Retinal fundus photograph · image size 2212x1659 · 45° FOV:
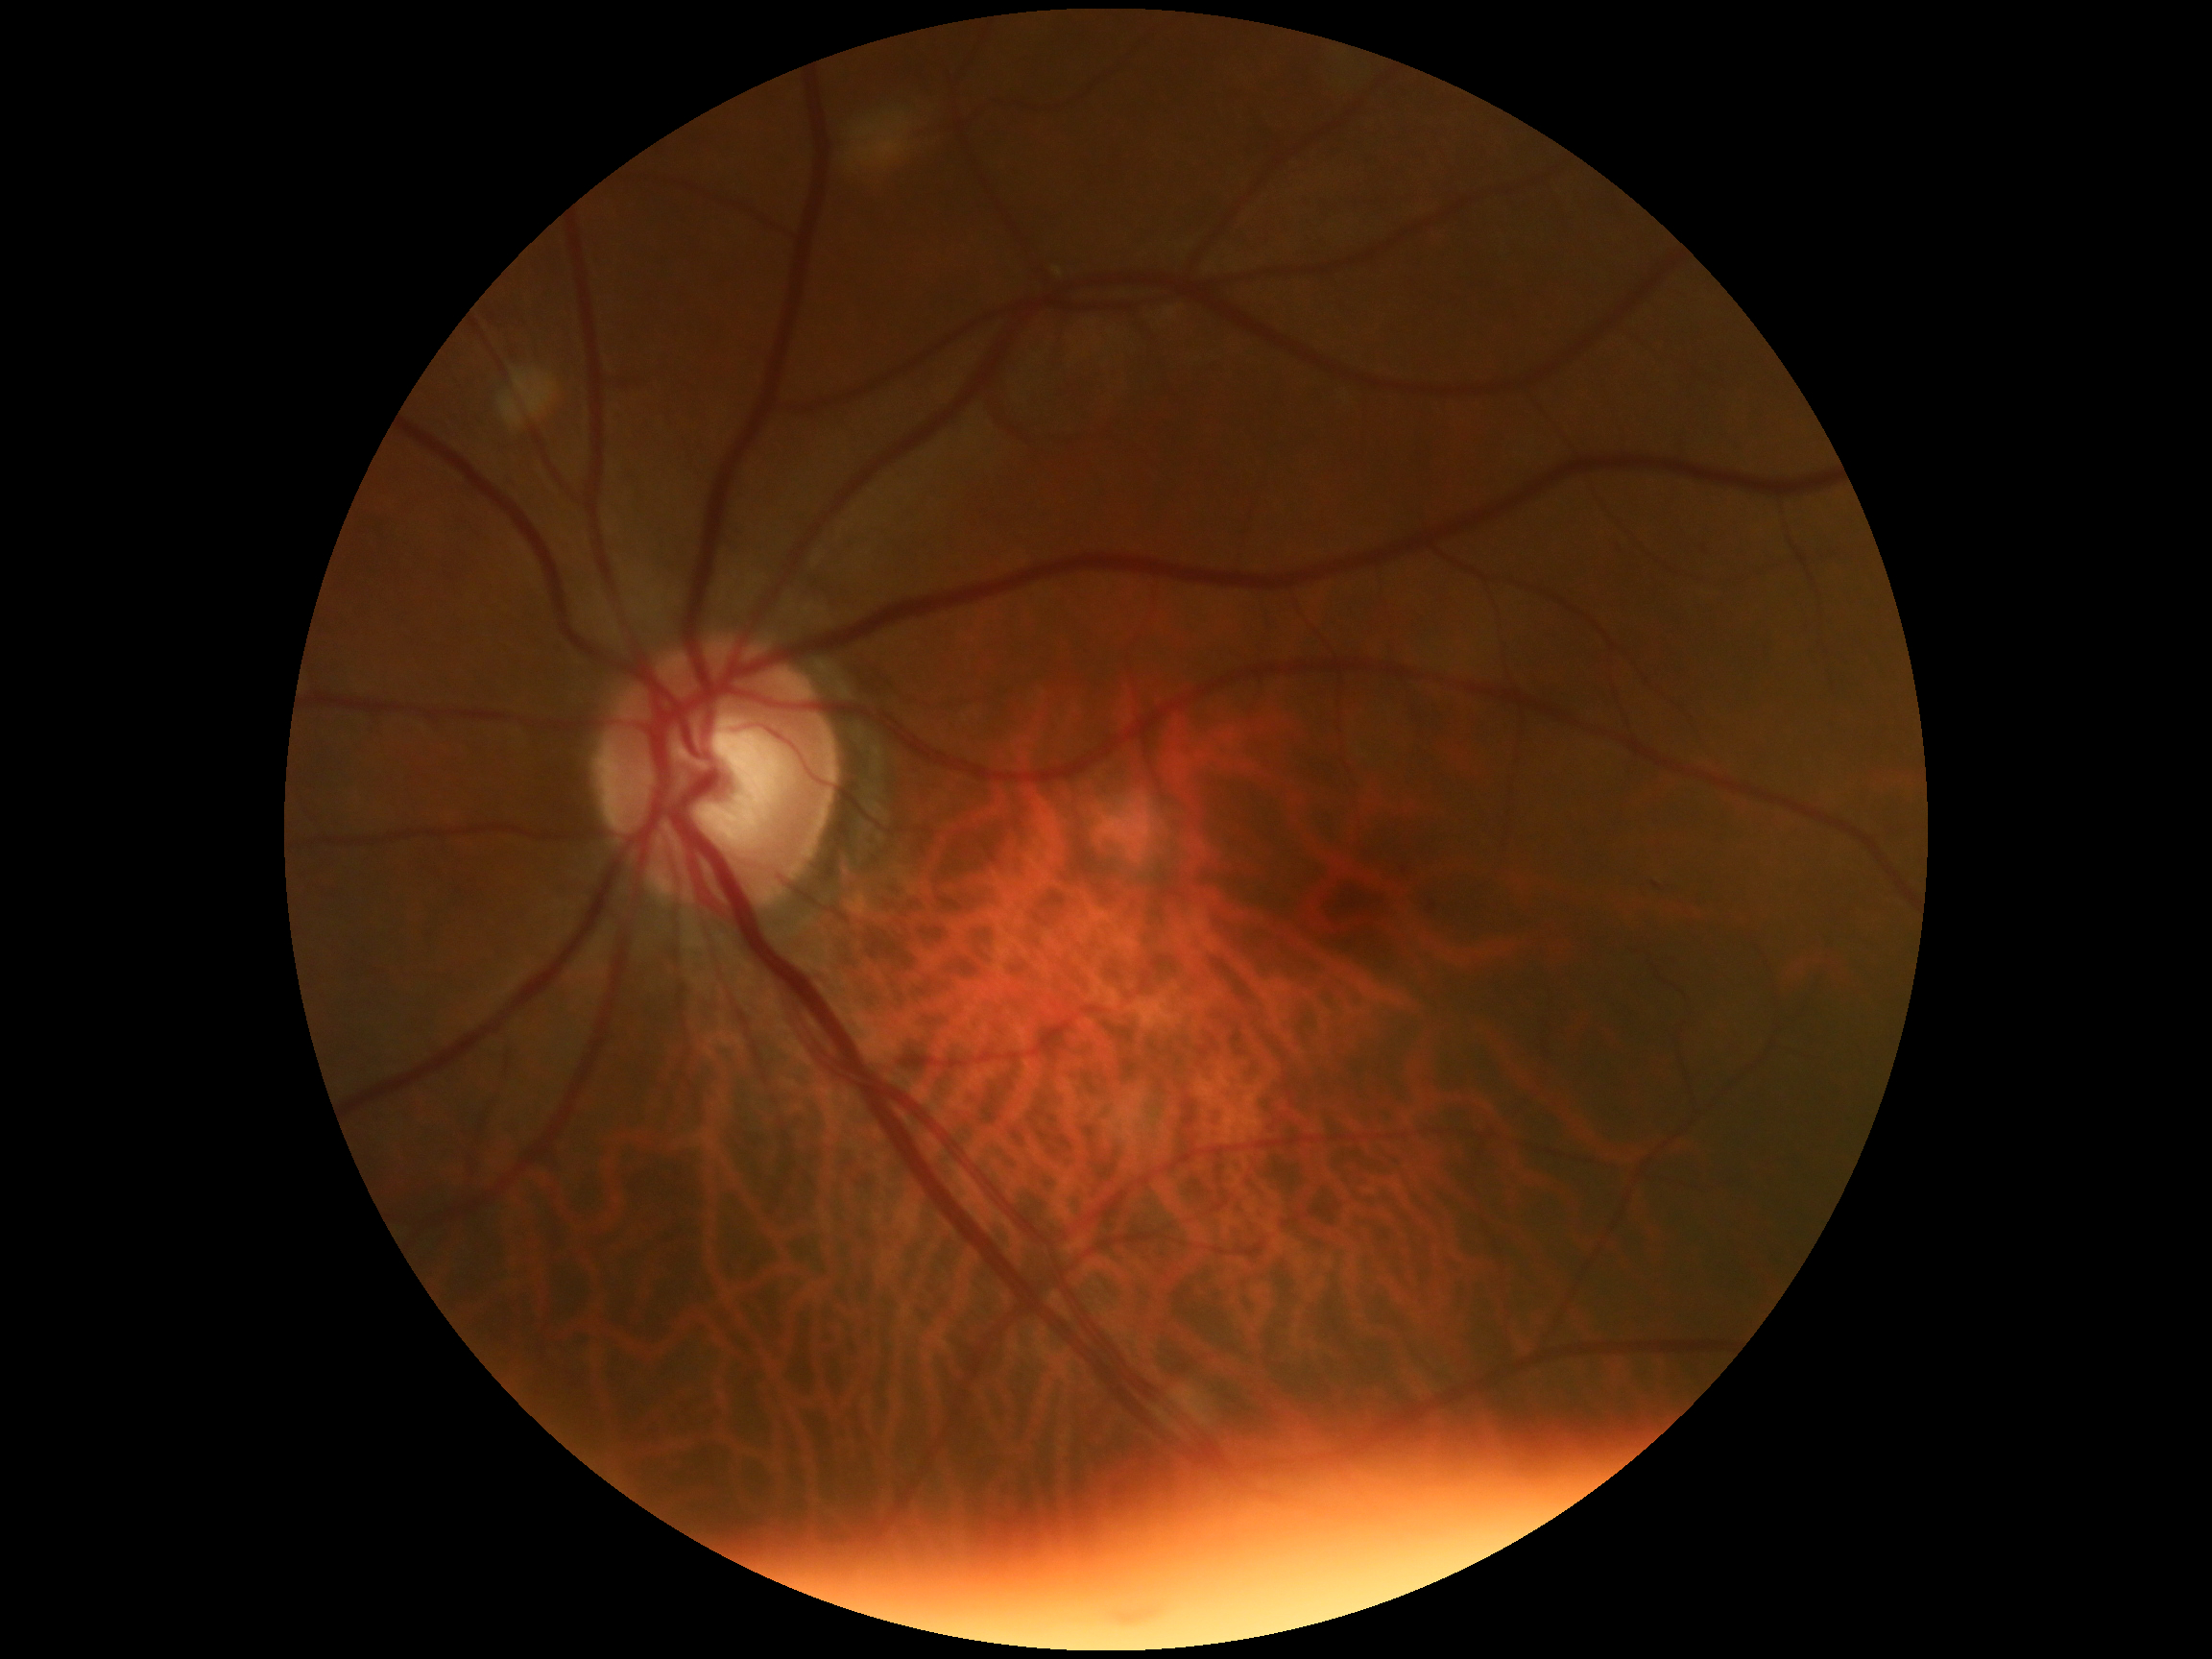

Diabetic retinopathy (DR) is 0/4.